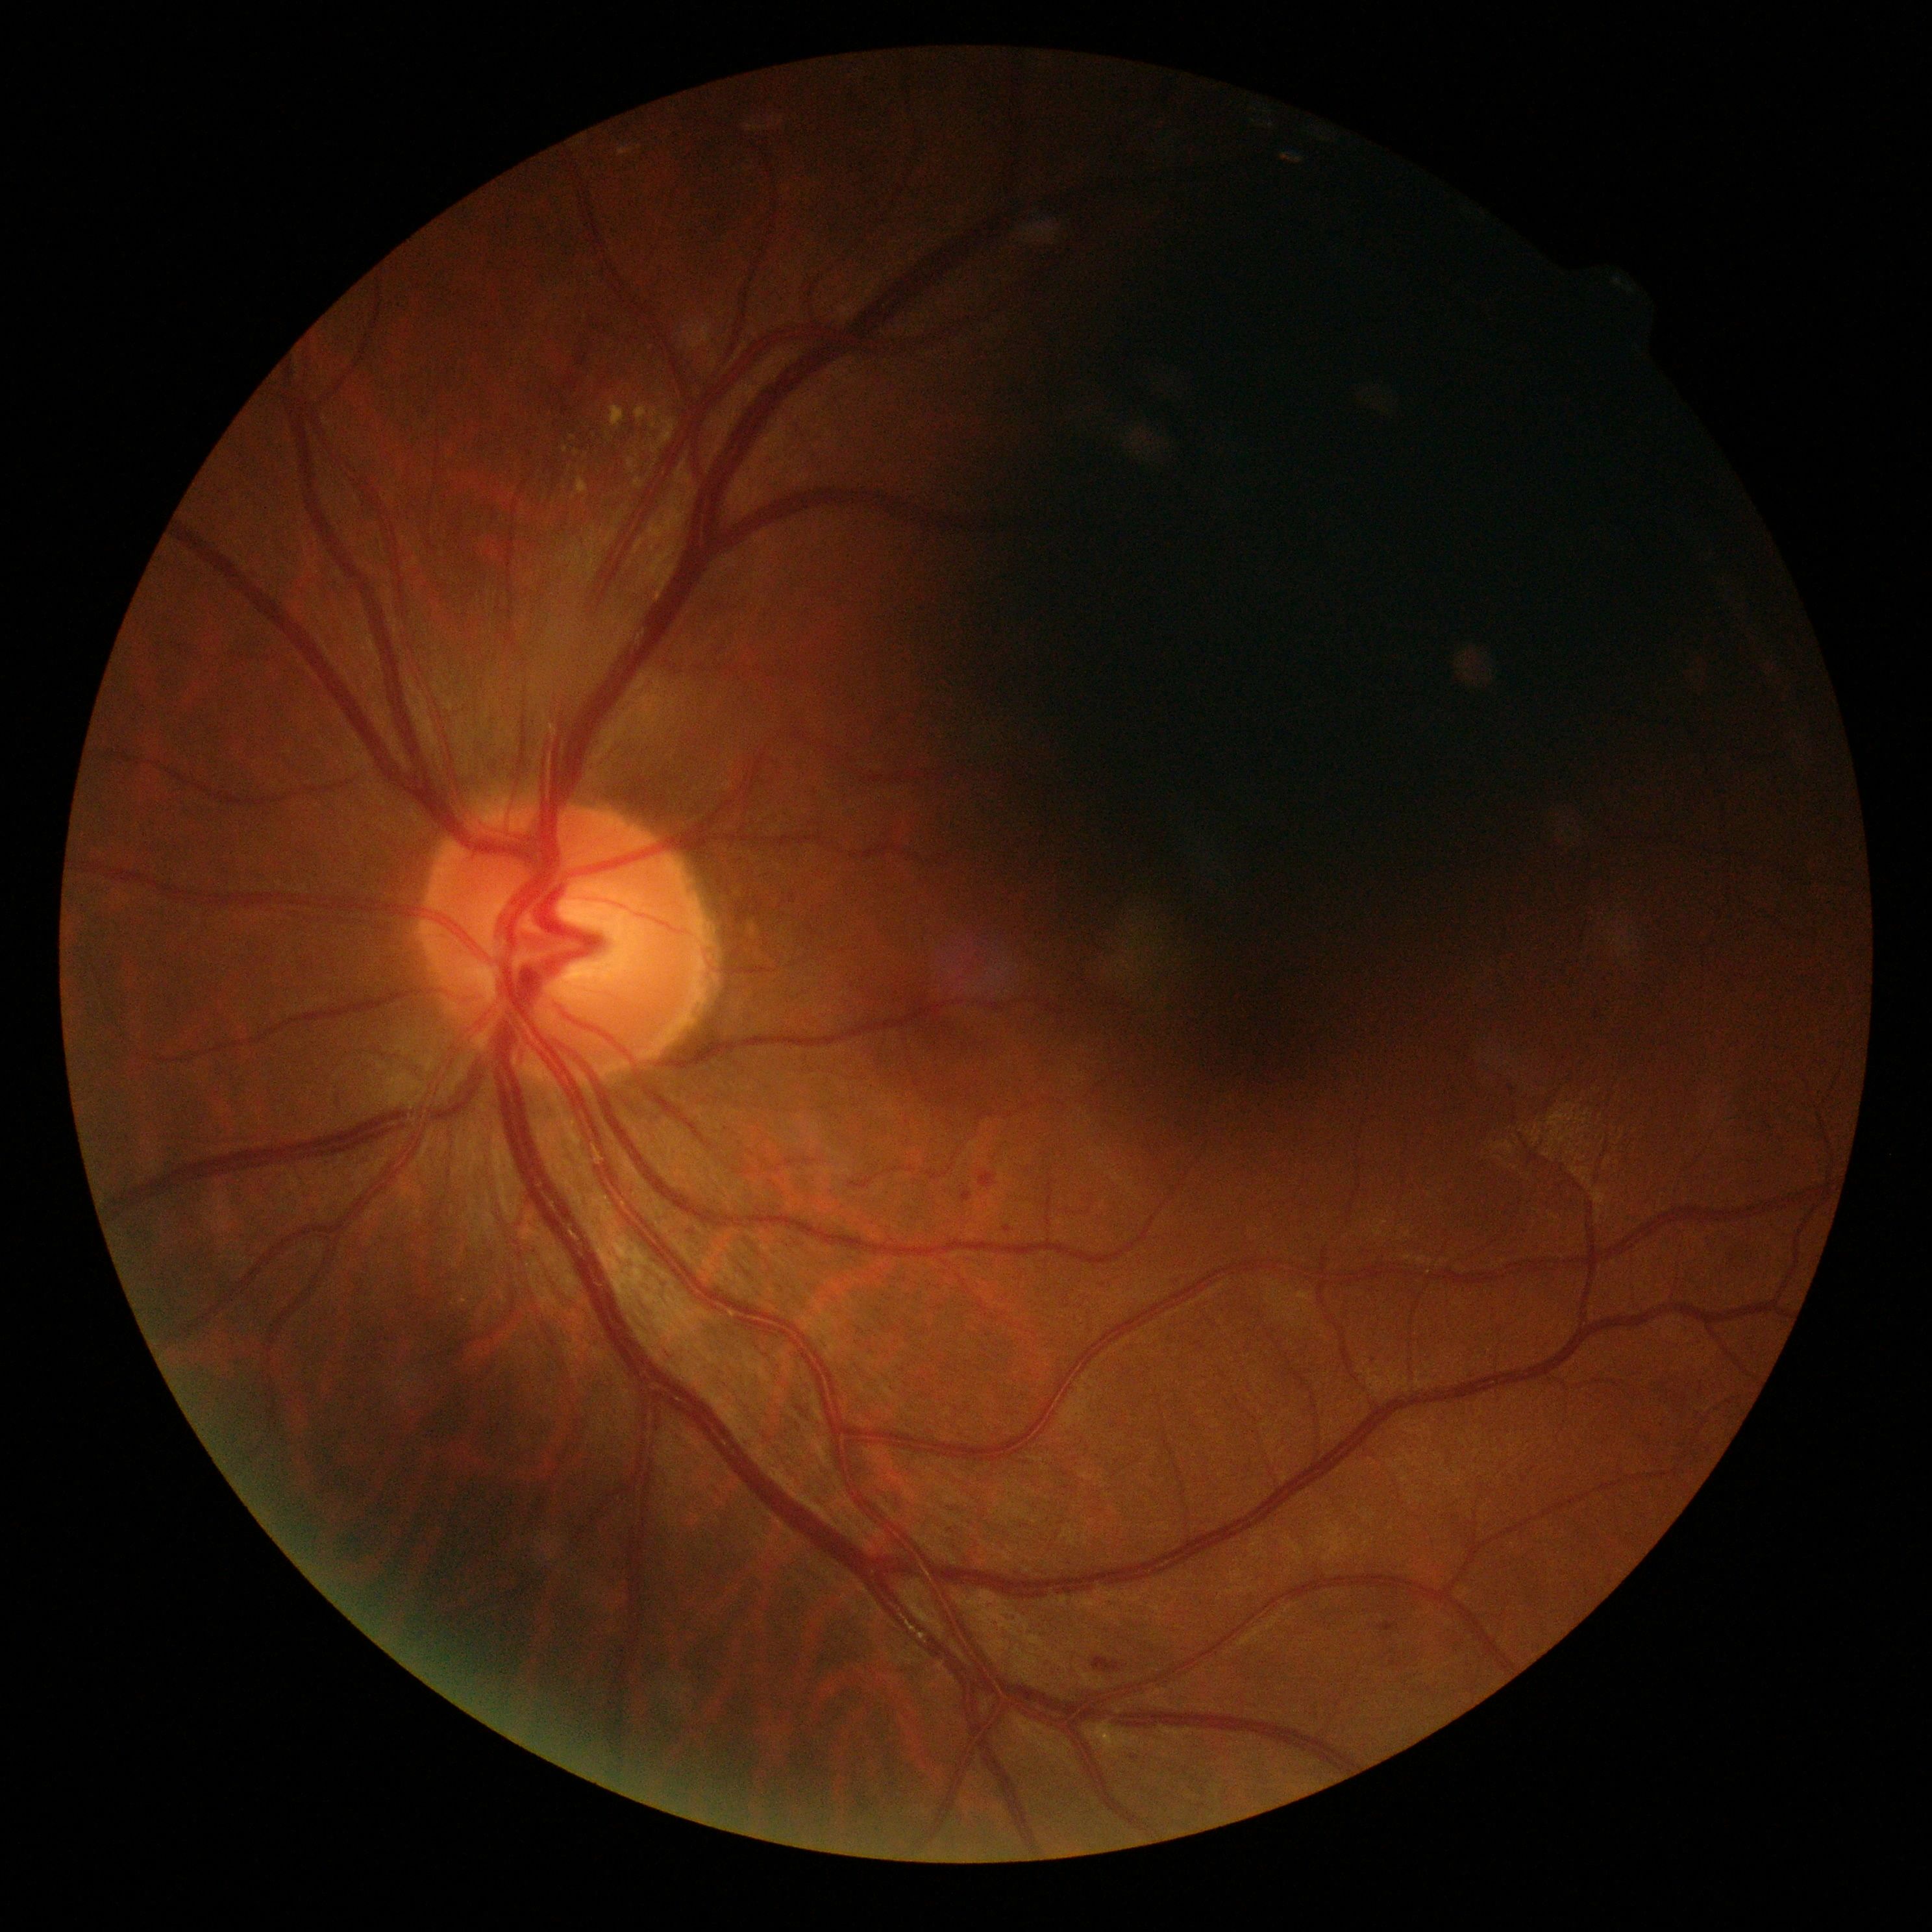
DR: grade 2 (moderate NPDR).